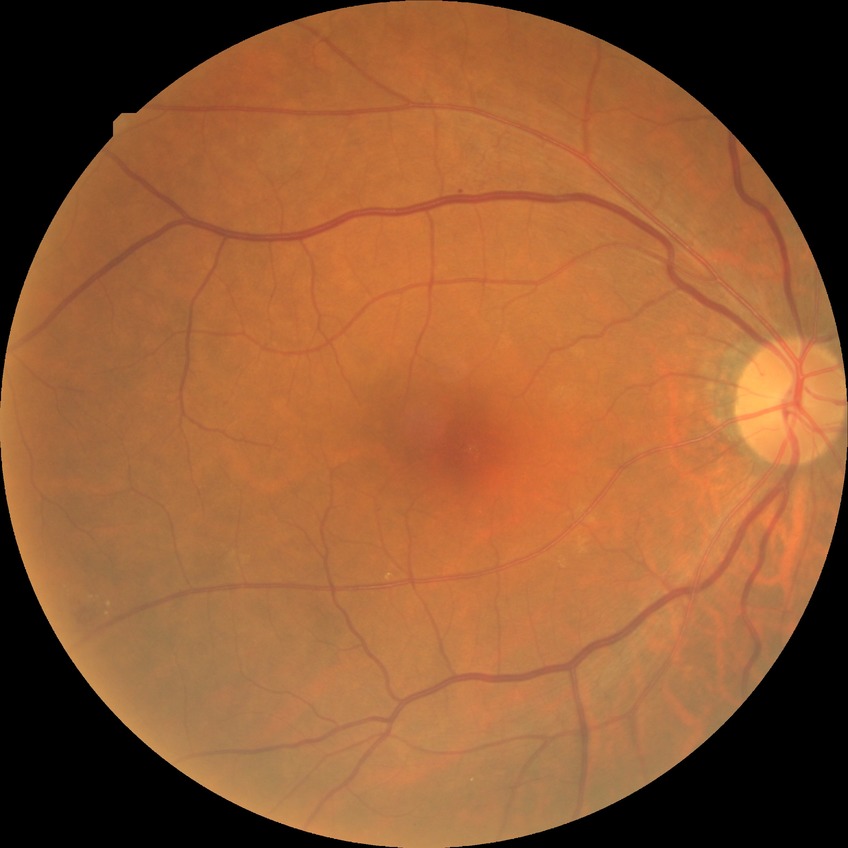 {"davis_grade": "SDR (simple diabetic retinopathy)"}